45° field of view. Retinal fundus photograph.
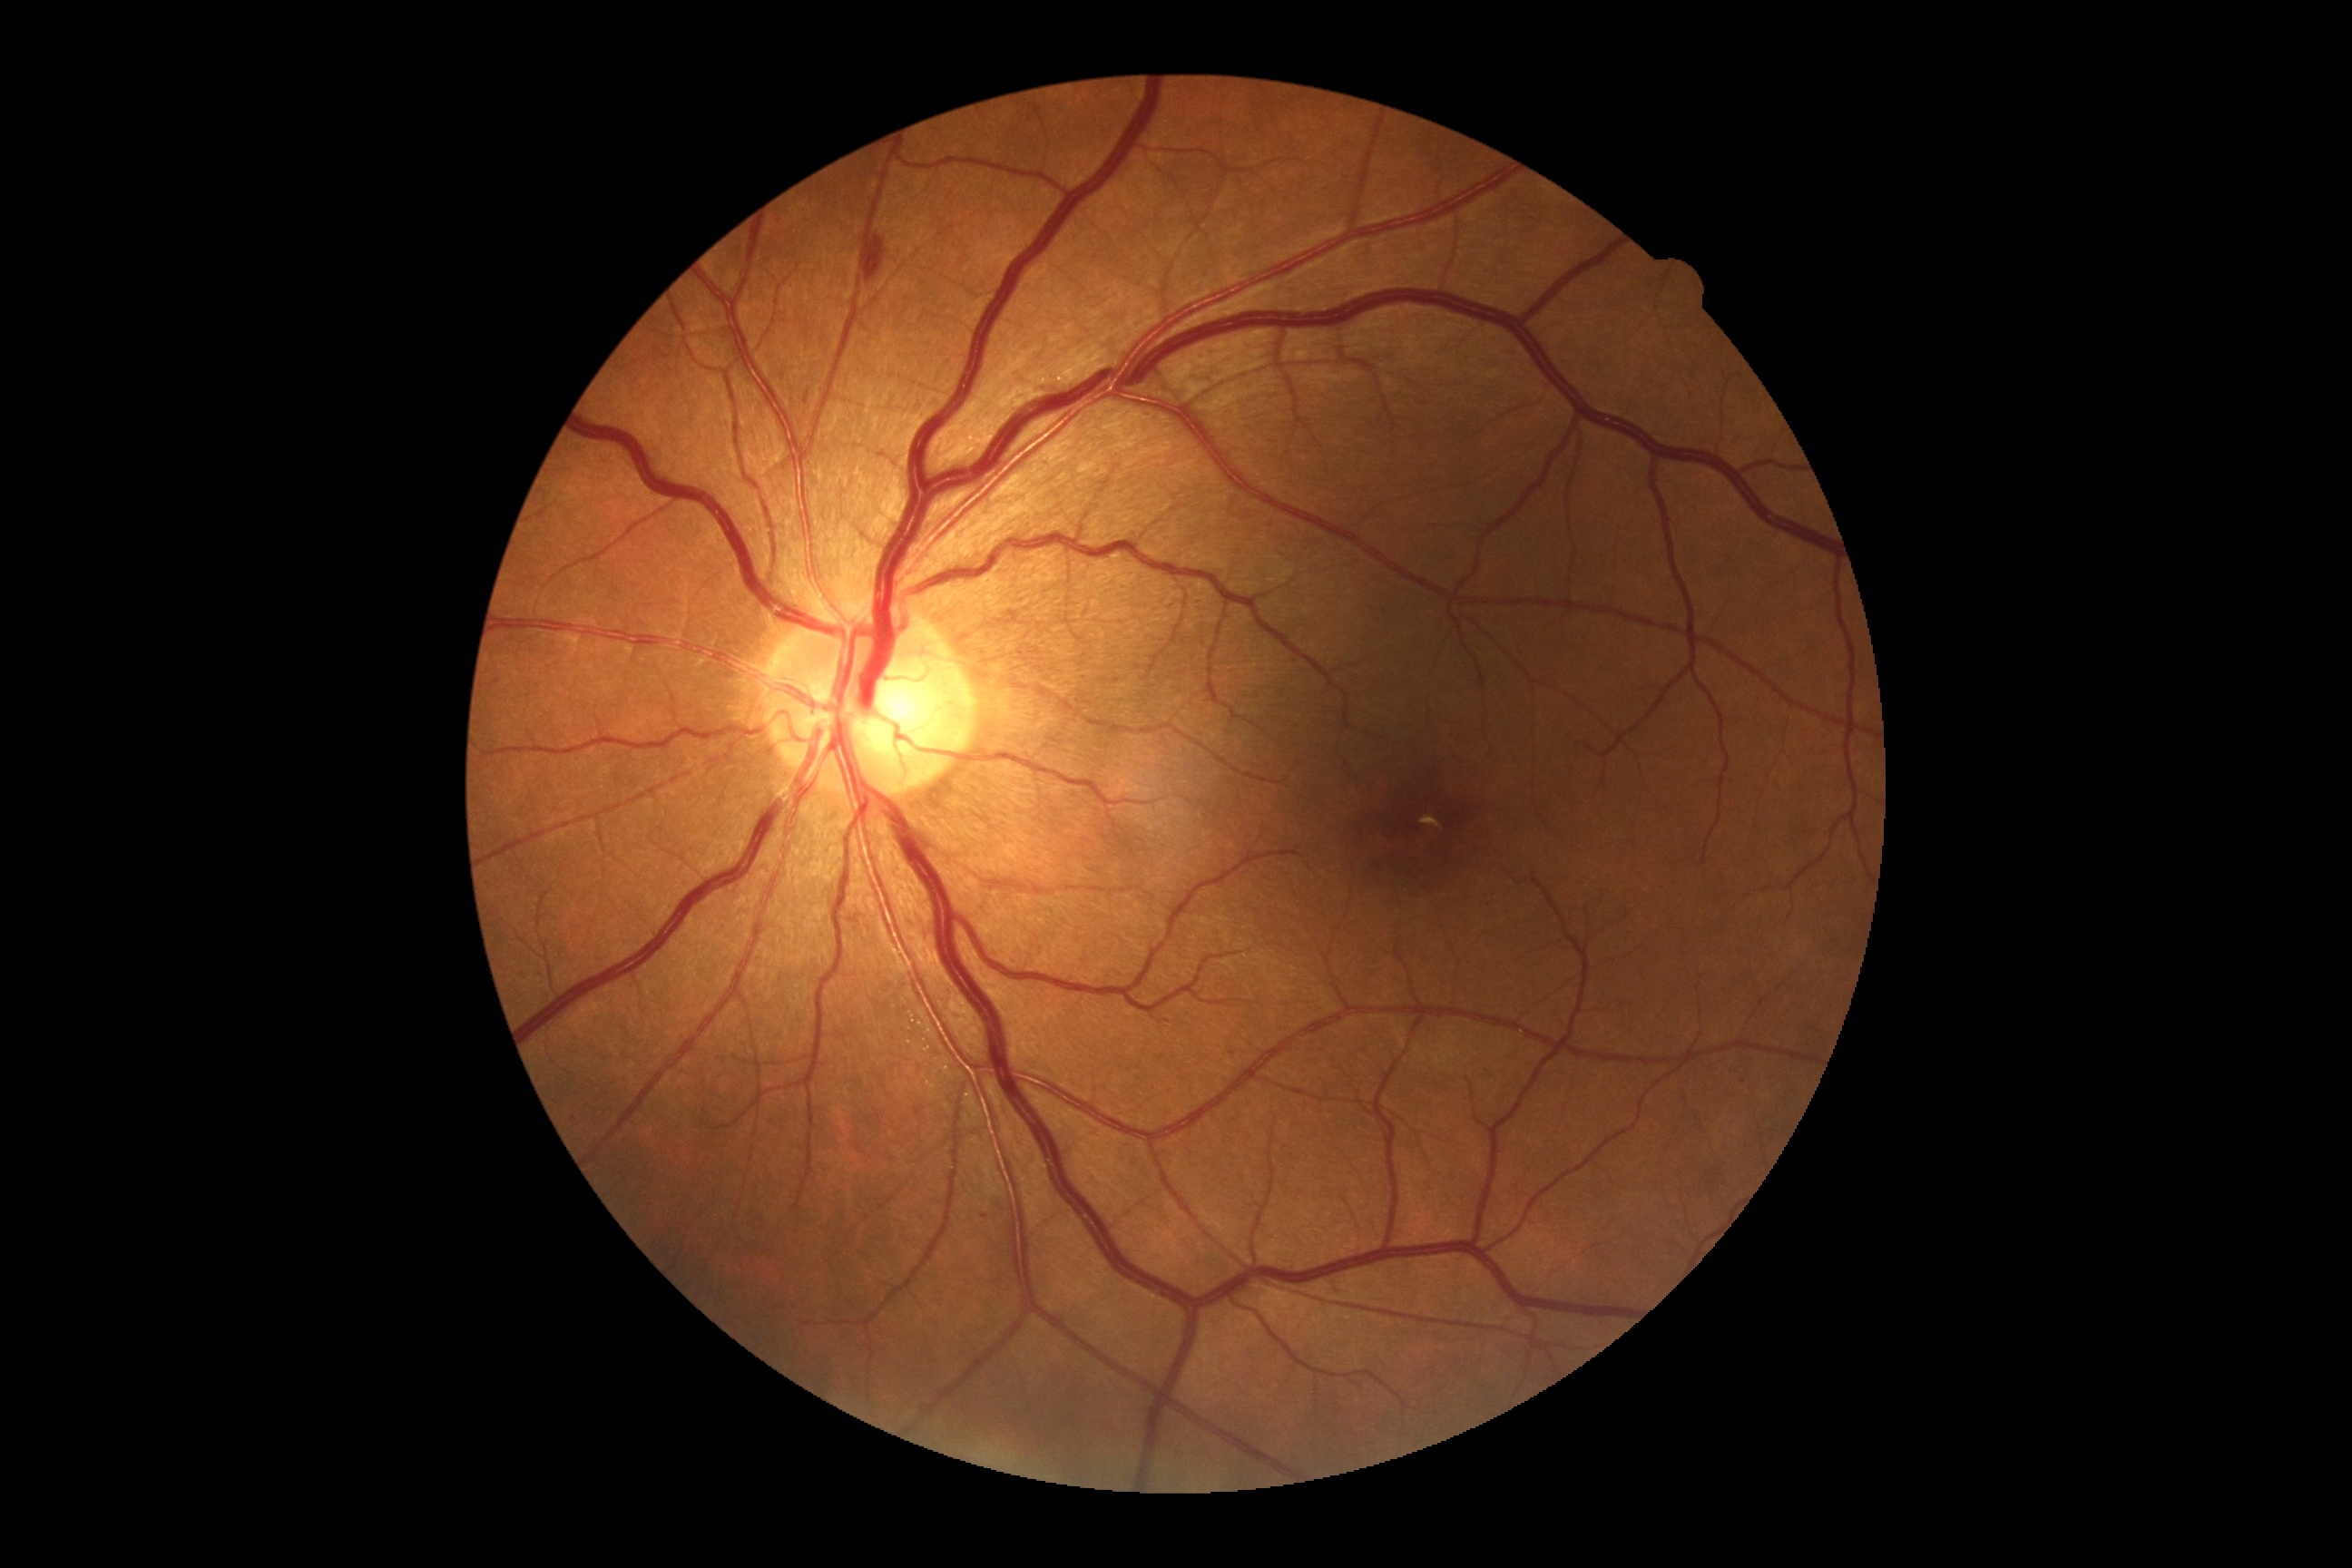

DR grade is 2.